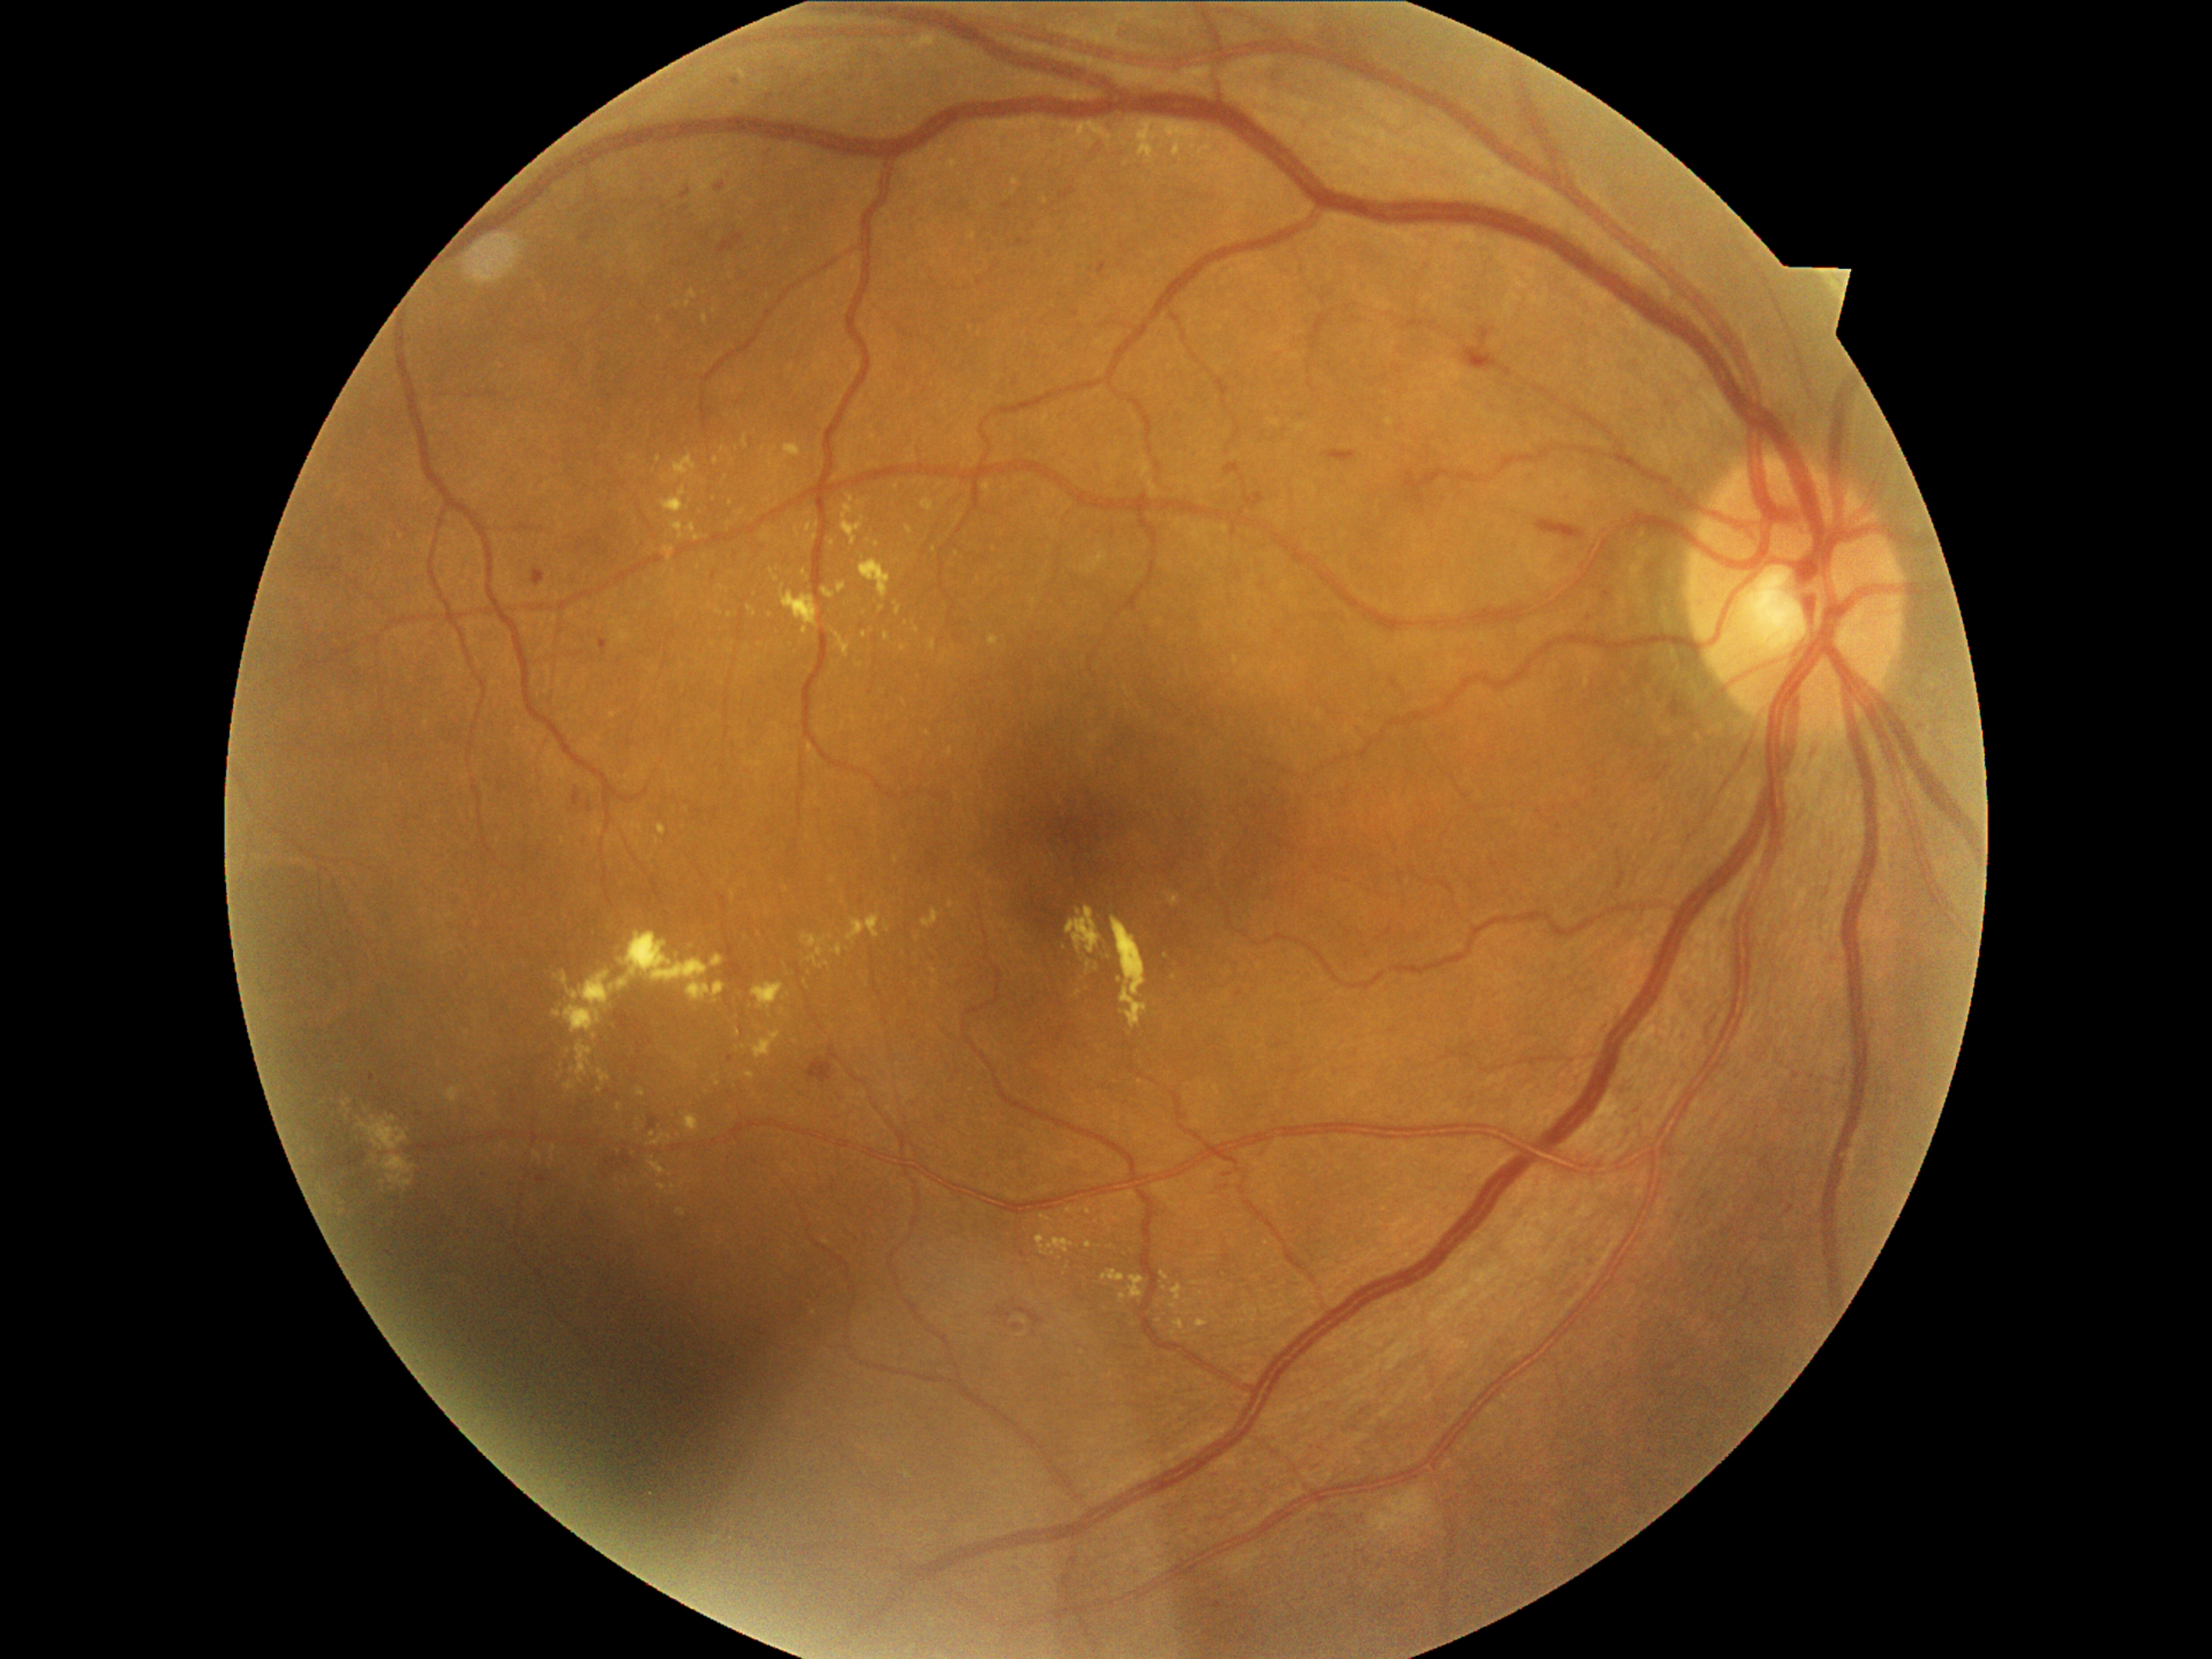

Diabetic retinopathy (DR) is moderate non-proliferative diabetic retinopathy (grade 2).
No soft exudates (SEs) identified.
Microaneurysms (MAs) are present, including at x1=532 y1=569 x2=545 y2=588; x1=537 y1=1175 x2=547 y2=1184; x1=1003 y1=202 x2=1013 y2=211; x1=682 y1=189 x2=692 y2=199; x1=714 y1=183 x2=726 y2=192; x1=1223 y1=1173 x2=1231 y2=1177; x1=598 y1=639 x2=608 y2=658; x1=1098 y1=264 x2=1107 y2=276; x1=649 y1=1117 x2=658 y2=1131; x1=1225 y1=465 x2=1245 y2=482; x1=1243 y1=494 x2=1264 y2=508.
Additional small MAs near 1226/1187; 730/1059; 372/1077.
Hemorrhages (HEs) found at x1=586 y1=800 x2=591 y2=813; x1=573 y1=793 x2=581 y2=806; x1=718 y1=233 x2=745 y2=255; x1=1464 y1=327 x2=1503 y2=373; x1=605 y1=1158 x2=619 y2=1168; x1=1013 y1=1322 x2=1025 y2=1332; x1=1015 y1=1308 x2=1044 y2=1325; x1=1535 y1=523 x2=1575 y2=532; x1=620 y1=1155 x2=634 y2=1165; x1=1322 y1=451 x2=1358 y2=465; x1=806 y1=1057 x2=834 y2=1085; x1=996 y1=1307 x2=1013 y2=1320.
Hard exudates (EXs) are present, including at x1=856 y1=663 x2=864 y2=668; x1=837 y1=583 x2=847 y2=595; x1=822 y1=586 x2=835 y2=600; x1=989 y1=636 x2=999 y2=646; x1=747 y1=1071 x2=755 y2=1081; x1=554 y1=933 x2=726 y2=1033; x1=858 y1=501 x2=868 y2=506; x1=1037 y1=1235 x2=1074 y2=1257; x1=767 y1=445 x2=803 y2=475; x1=649 y1=1158 x2=667 y2=1177; x1=689 y1=523 x2=696 y2=533; x1=658 y1=1184 x2=667 y2=1190.
Additional small EXs near 1022/1335; 832/542; 1069/1210; 818/526; 719/612; 719/357; 917/939.